848 x 848 pixels: 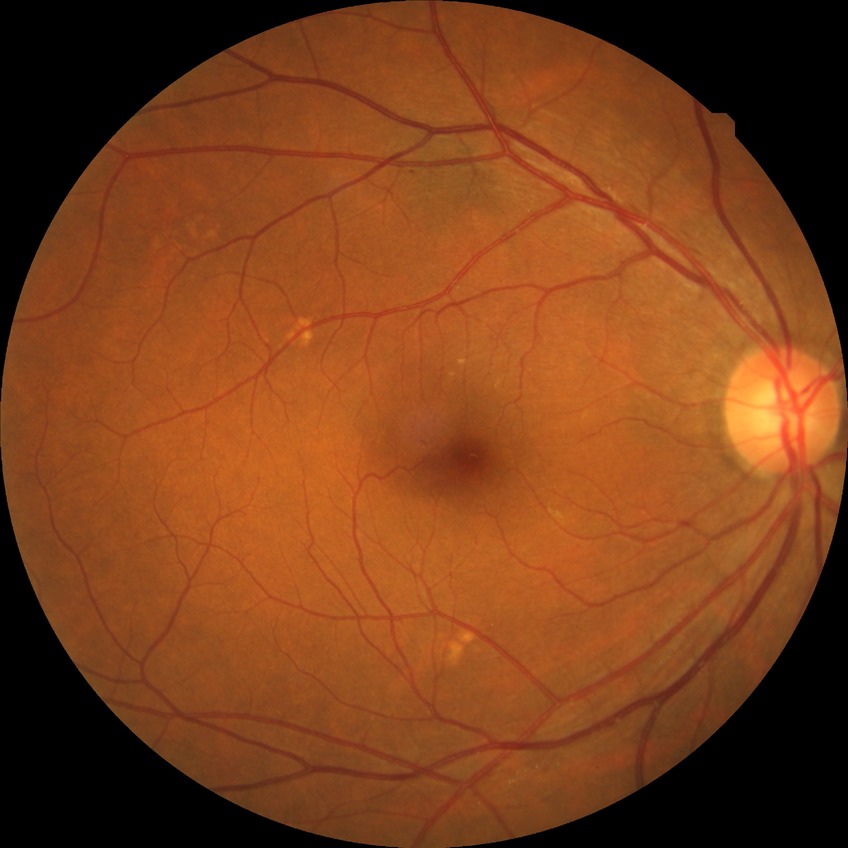
Diabetic retinopathy (DR) is no diabetic retinopathy (NDR).